Color fundus photograph: 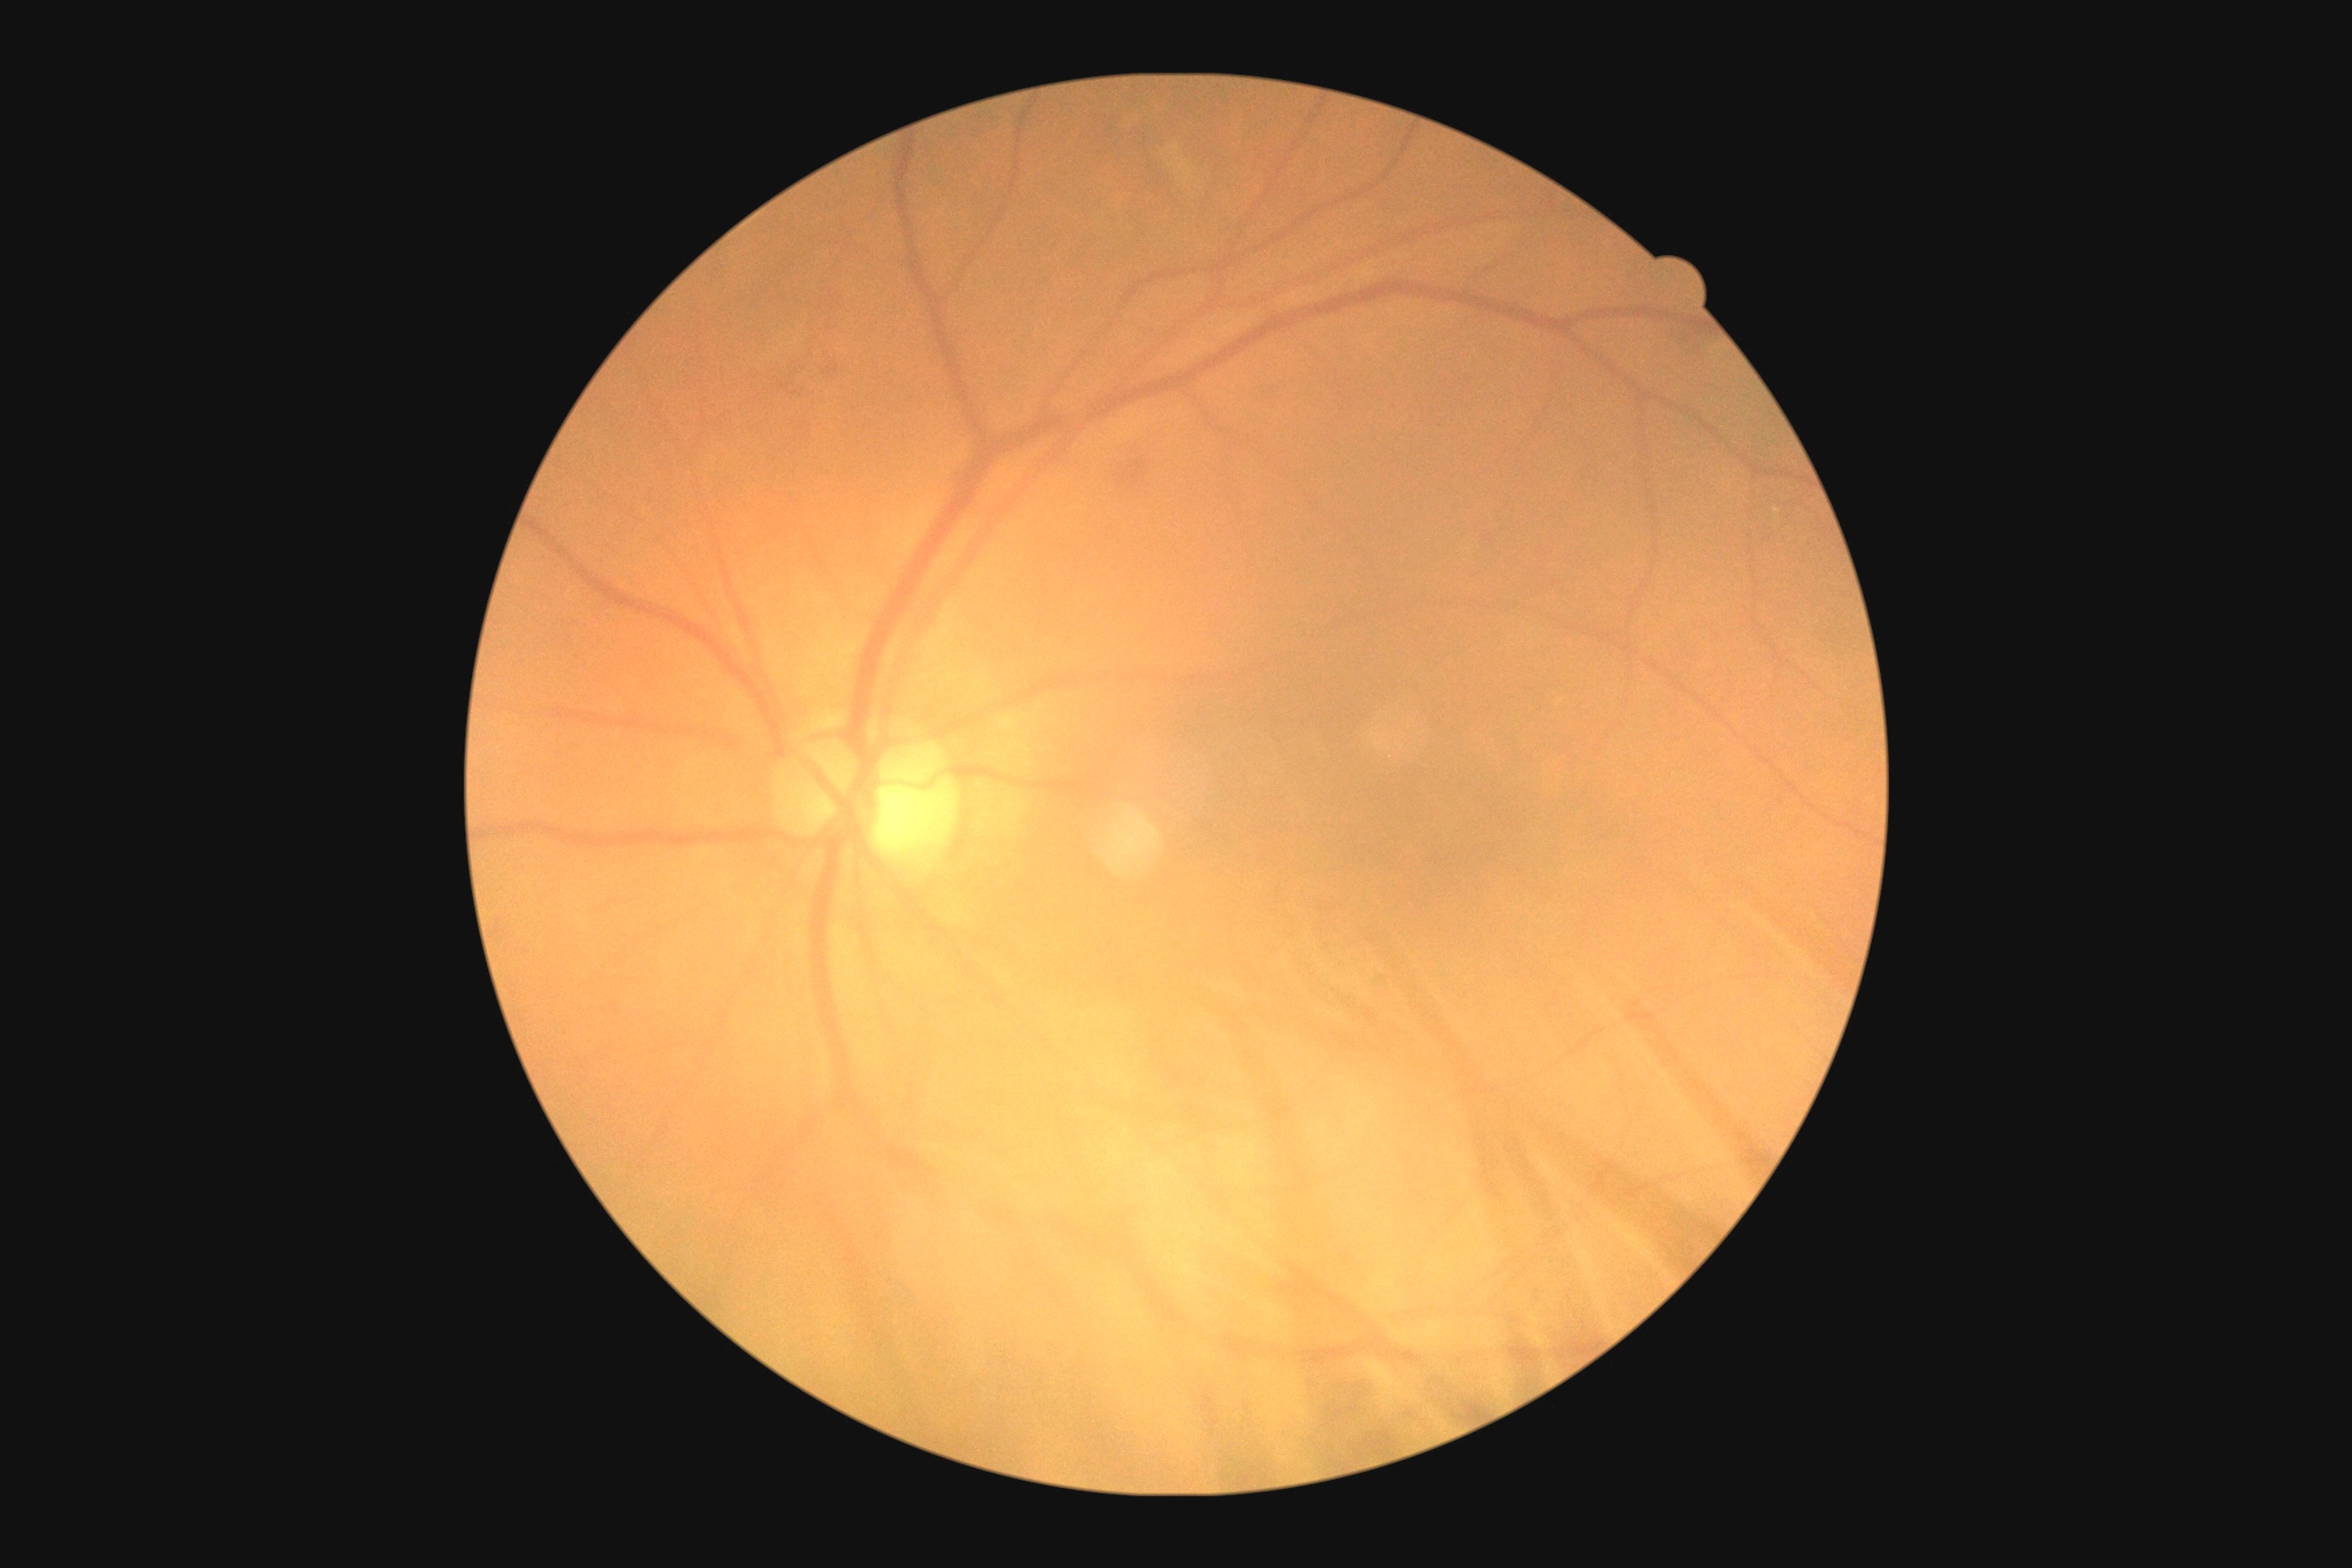

Findings:
• retinopathy grade: 2 (moderate NPDR)